CFP — 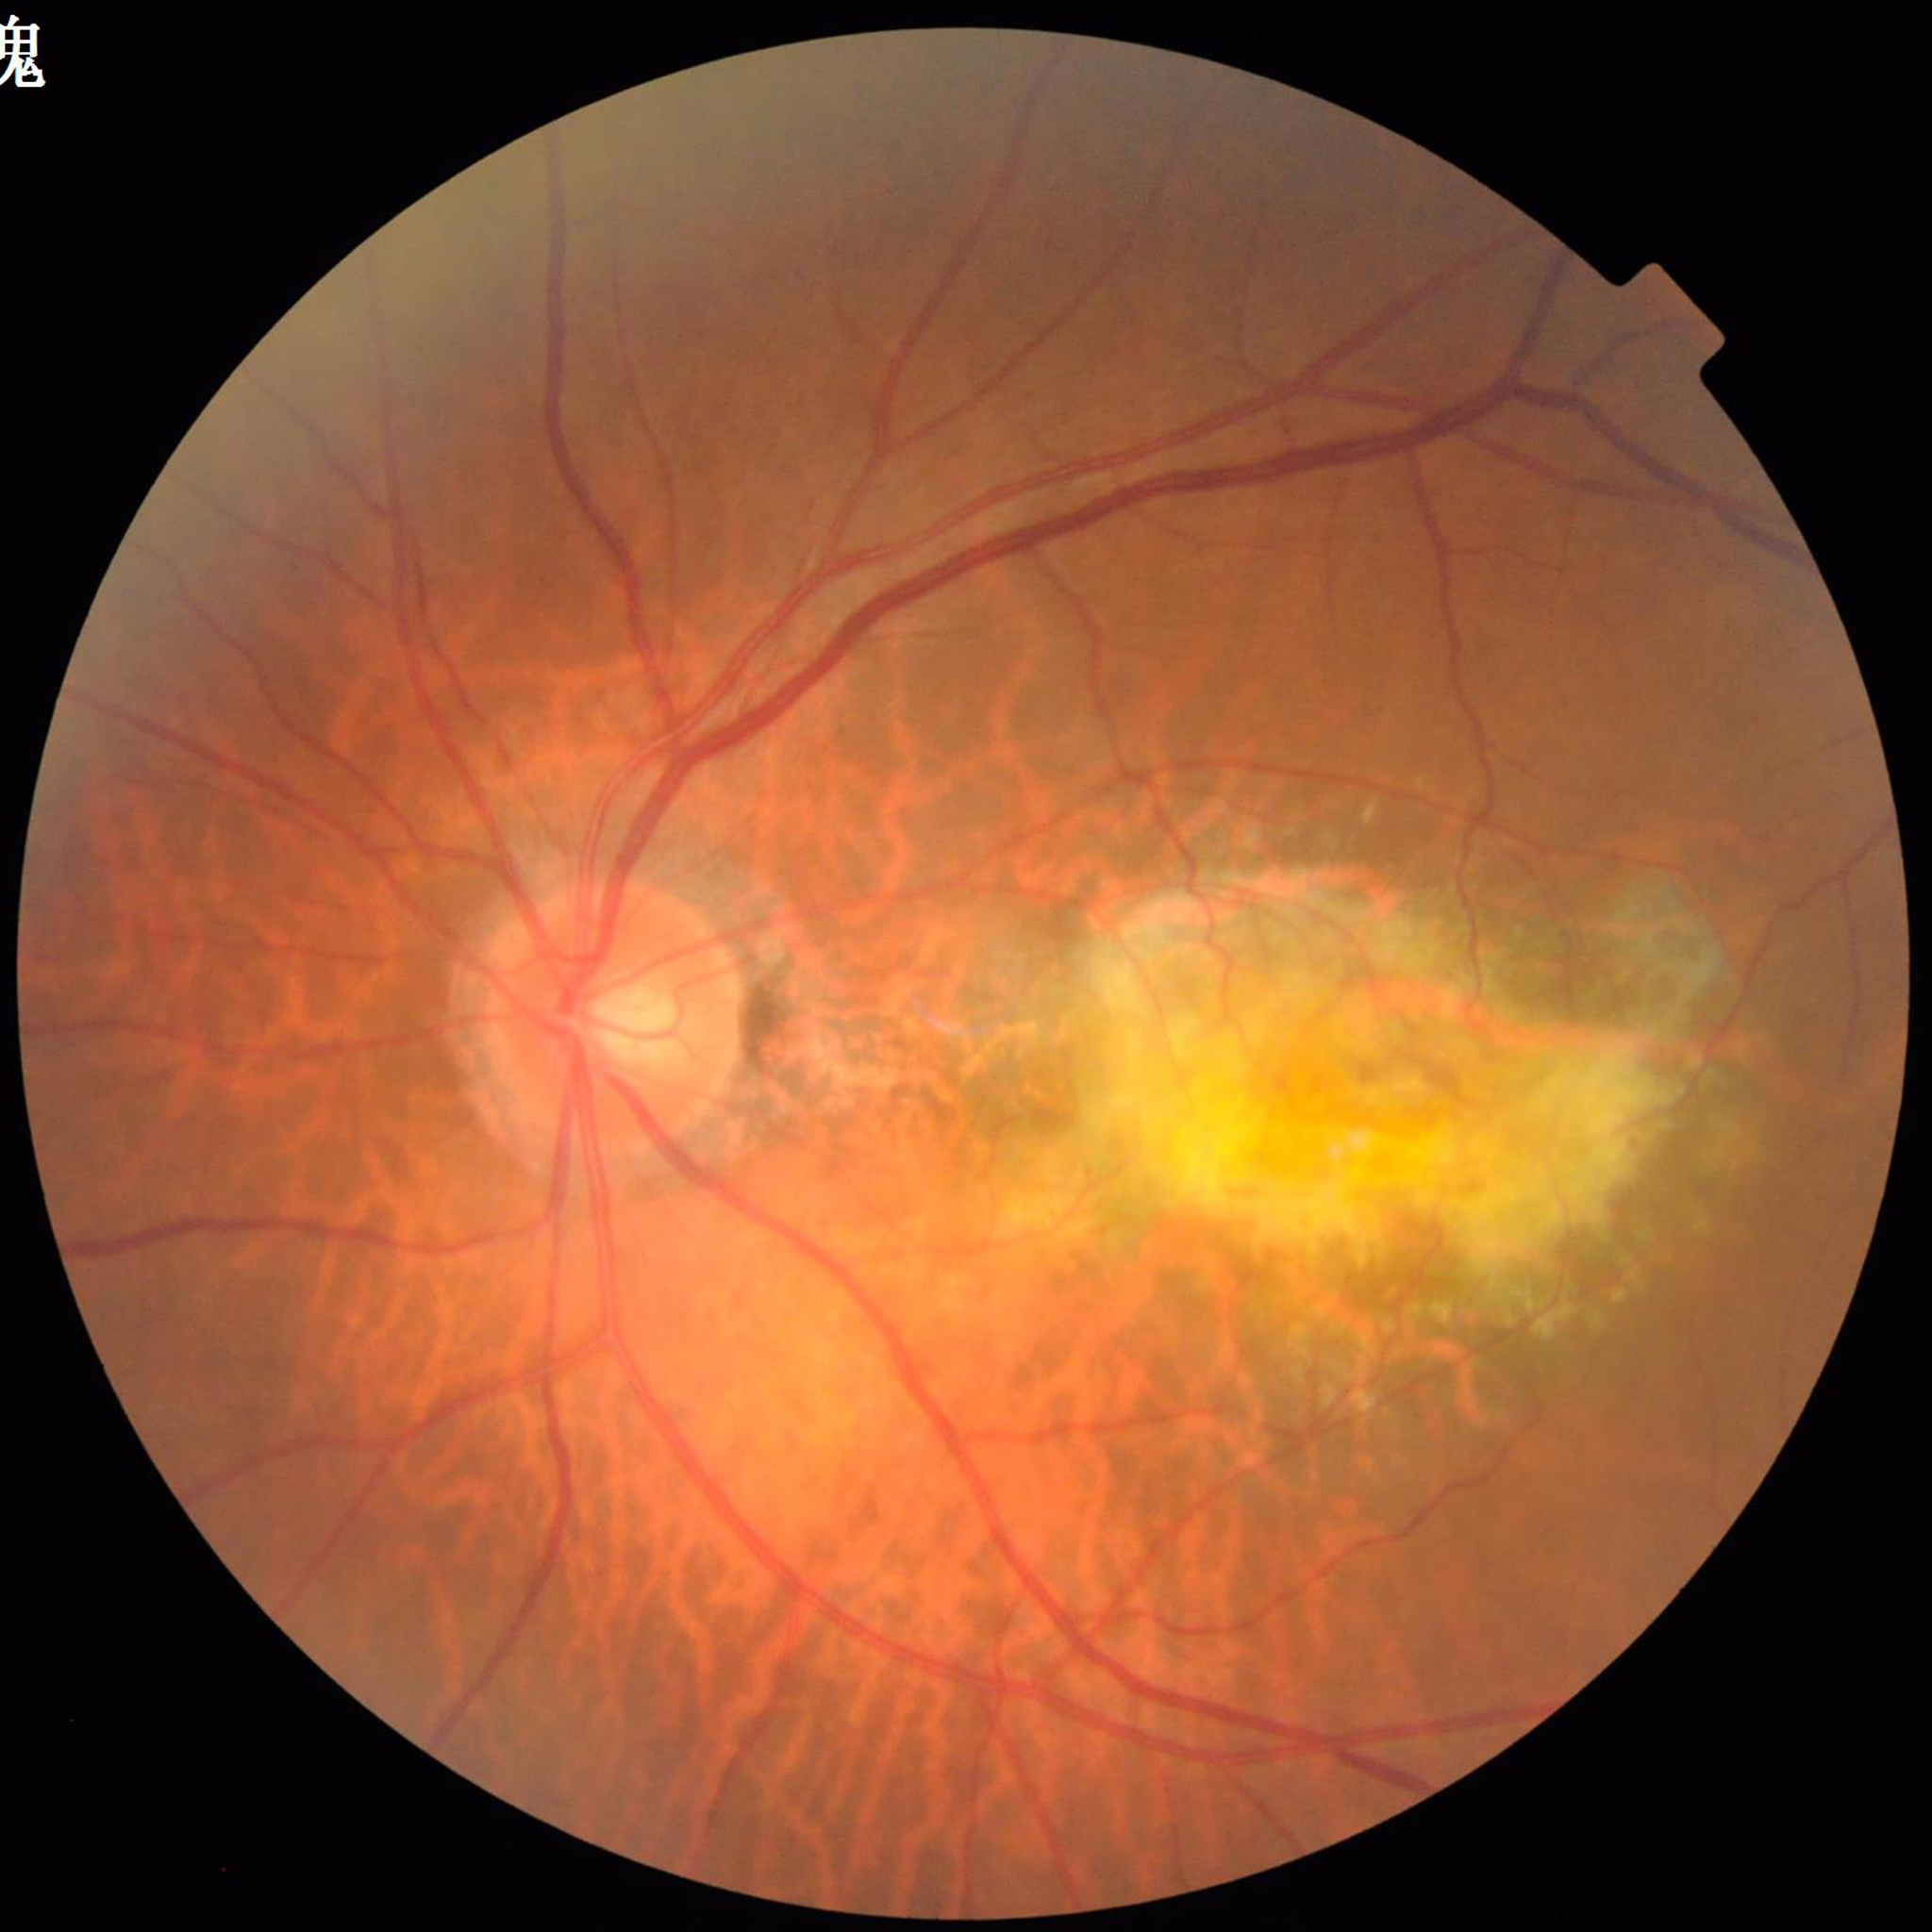
From a patient with age-related macular degeneration.